Phoenix ICON wide-field infant fundus image · 100° field of view (Phoenix ICON) — 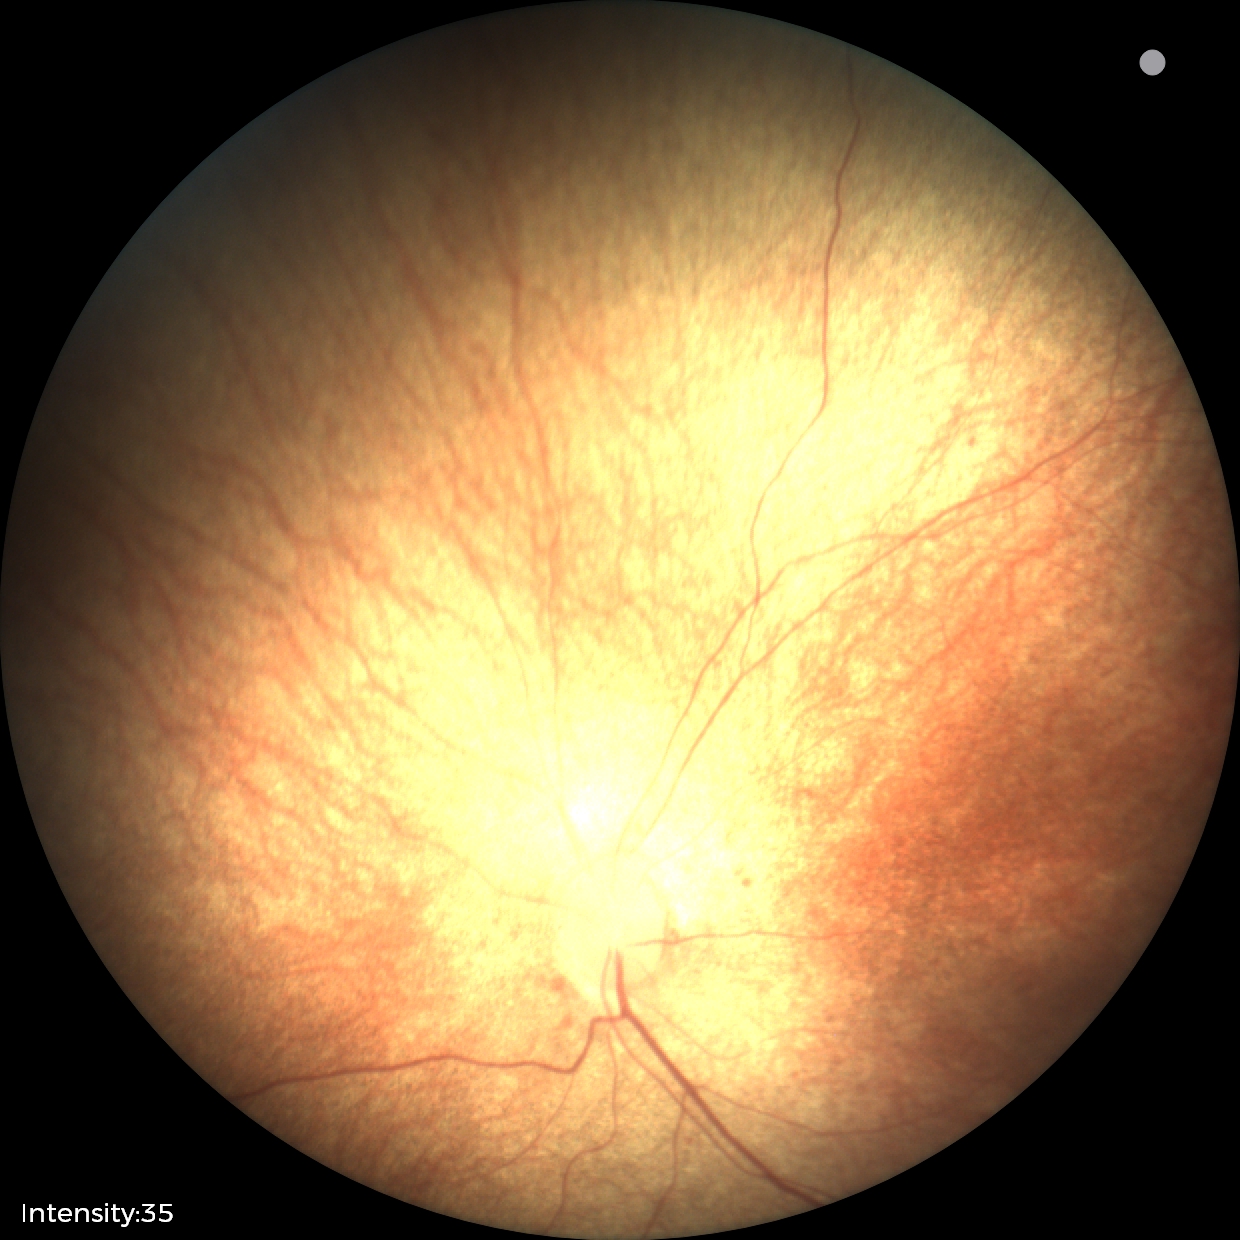

Finding = physiological appearance.